1659 by 2212 pixels. Color fundus photograph. Captured on a Remidio FOP fundus camera: 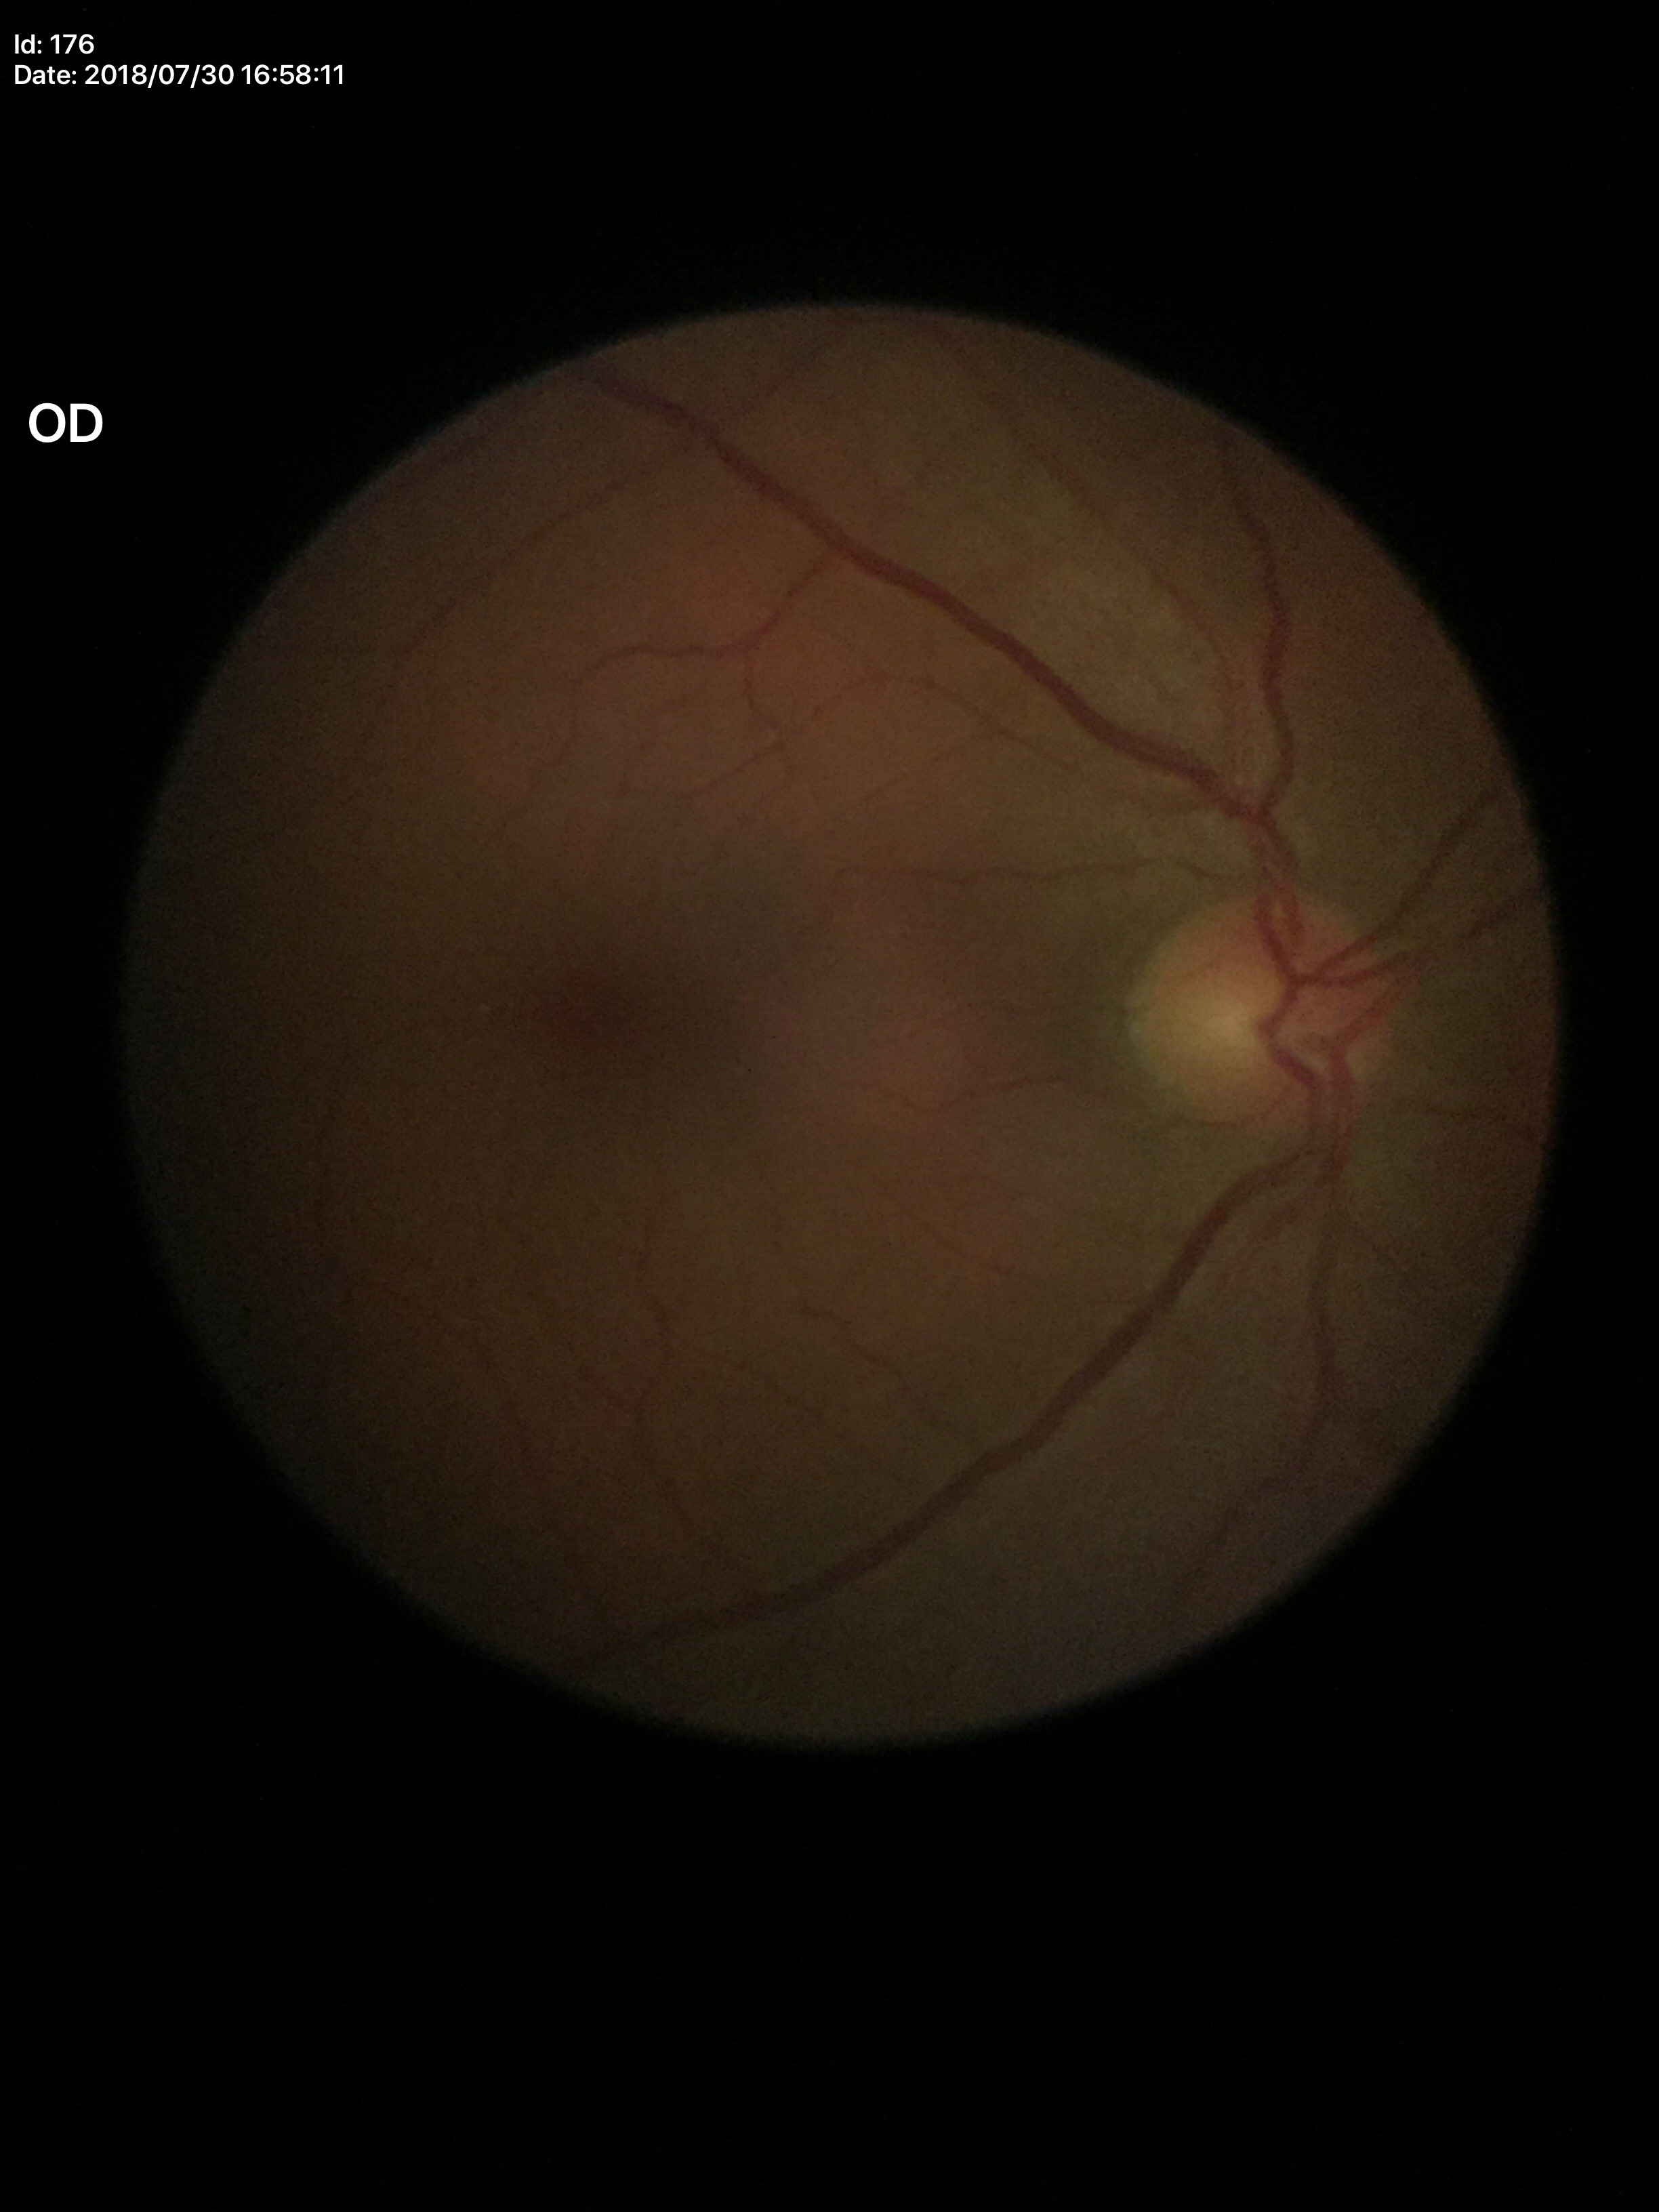 No evidence of glaucoma. Horizontal CDR of 0.49. Vertical C/D ratio: 0.49.